Image size 2352x1568: 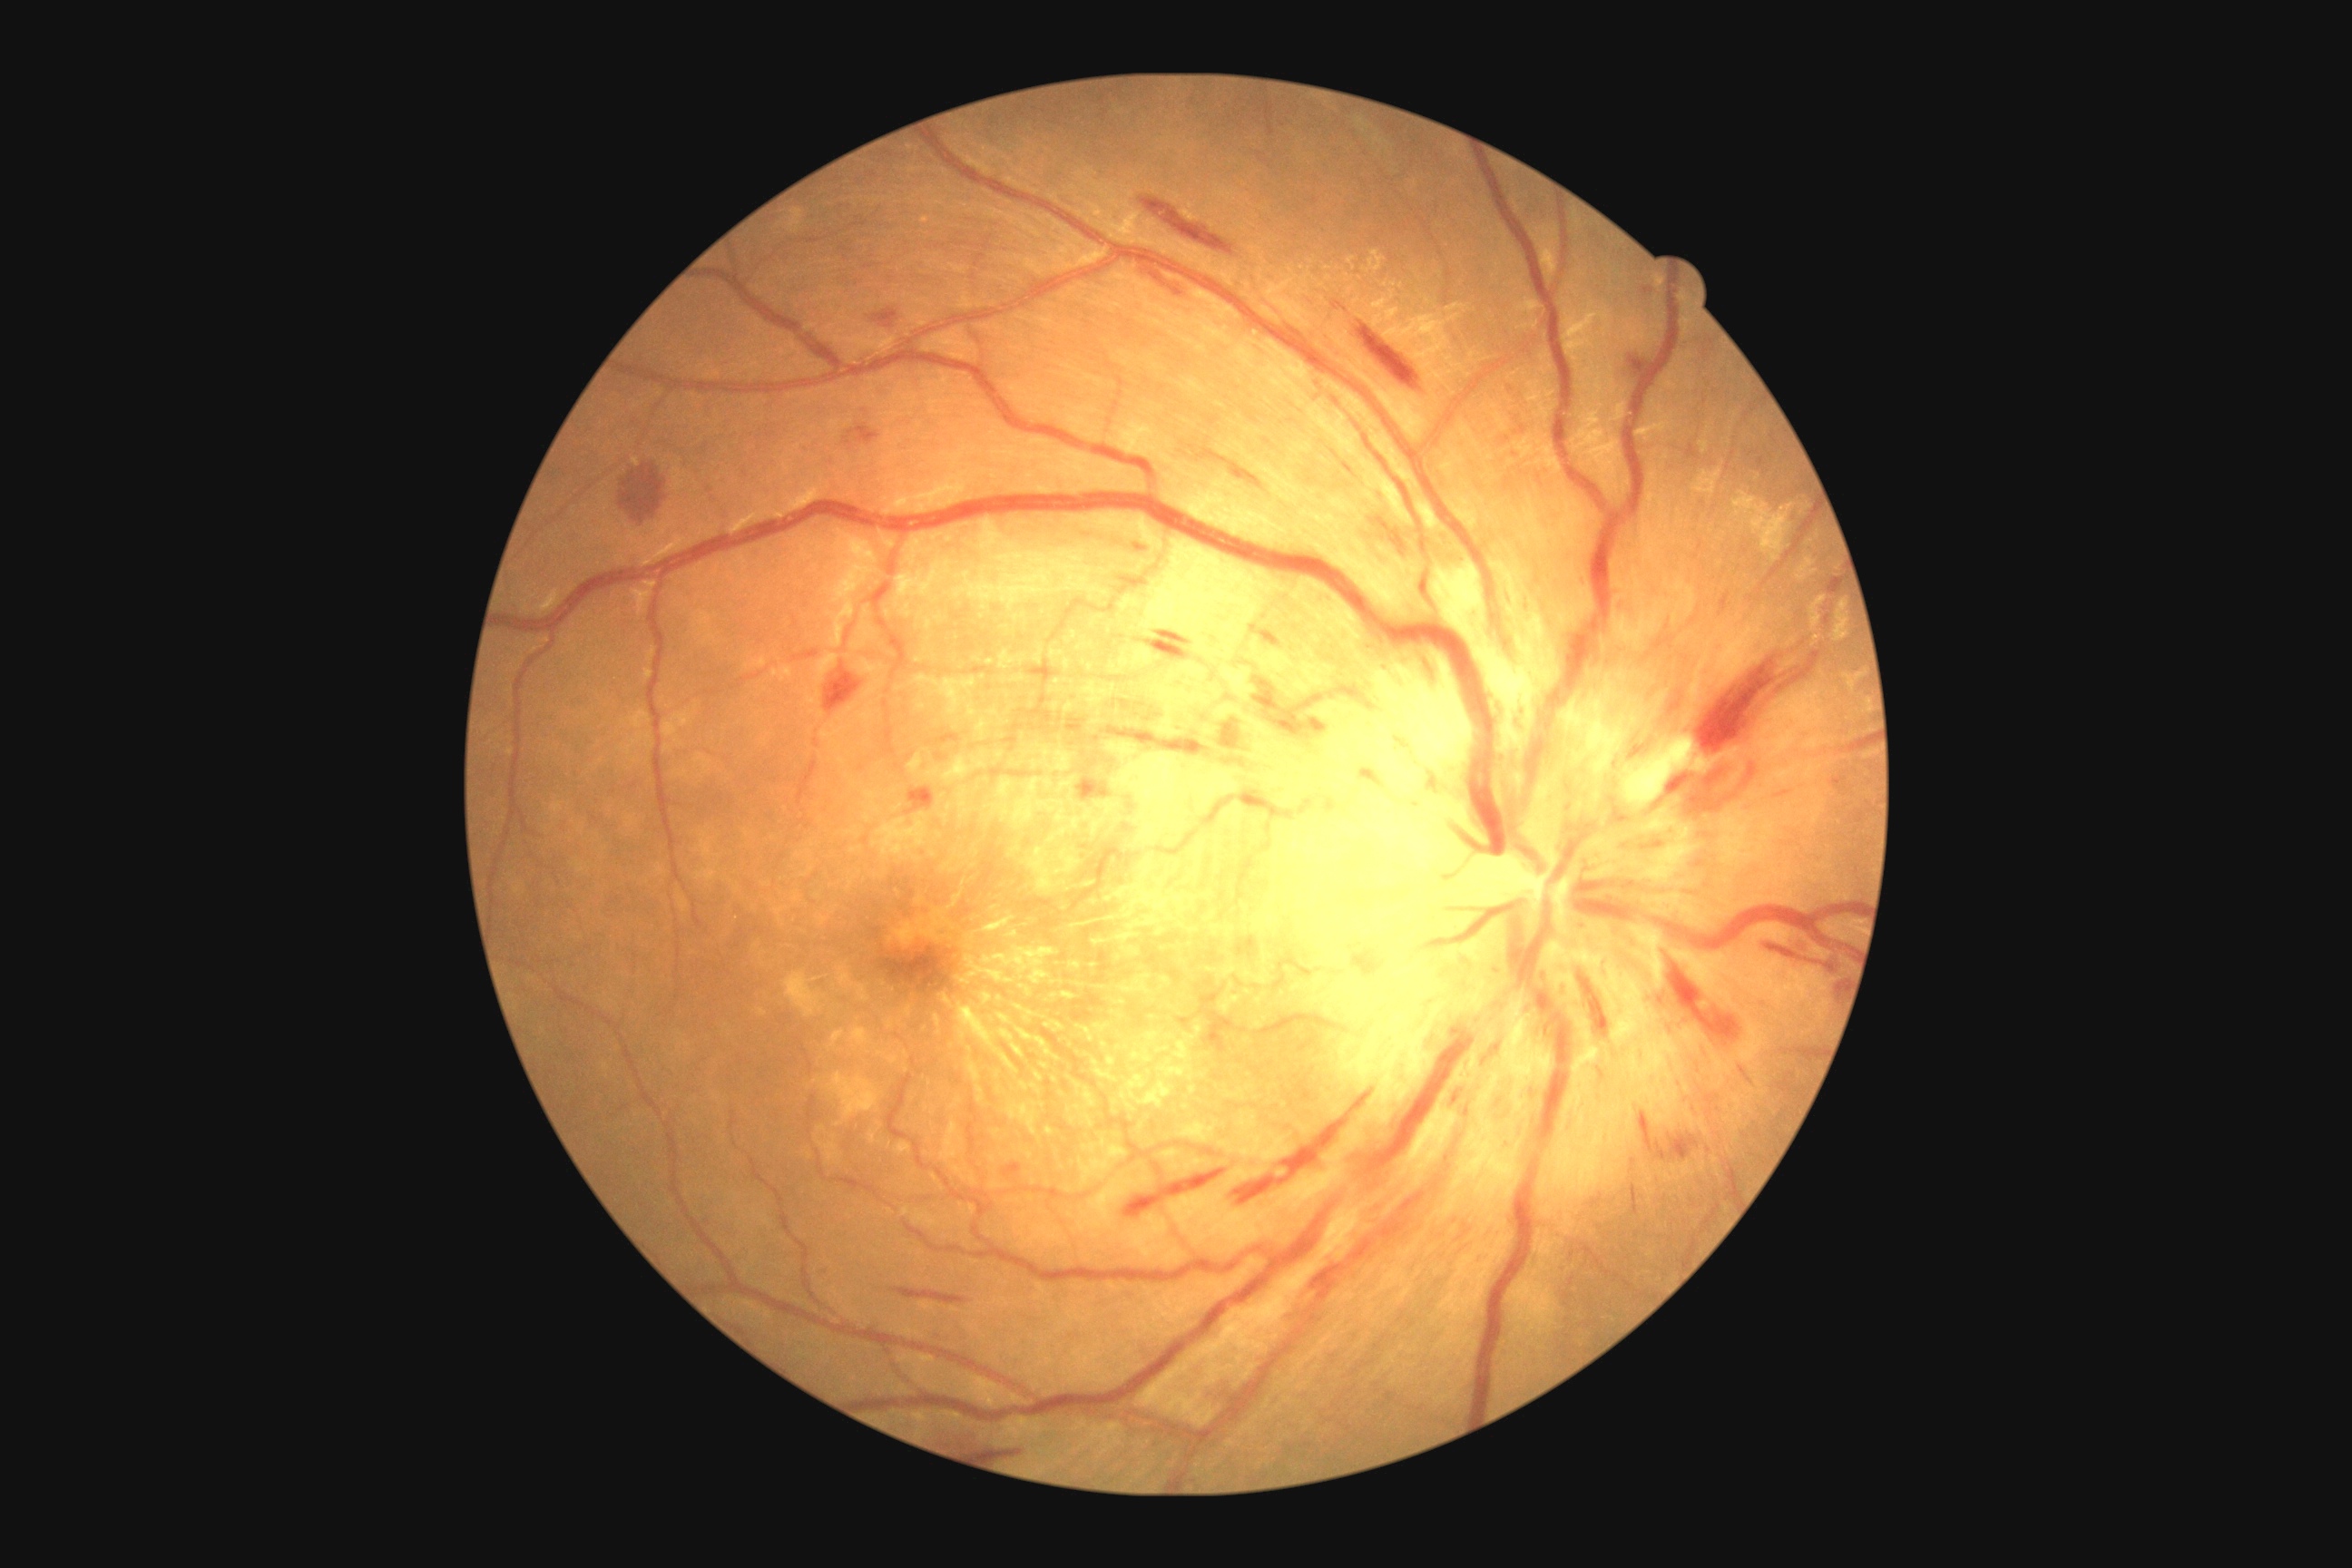 Diabetic retinopathy severity: moderate non-proliferative diabetic retinopathy (grade 2).